Without pupil dilation.
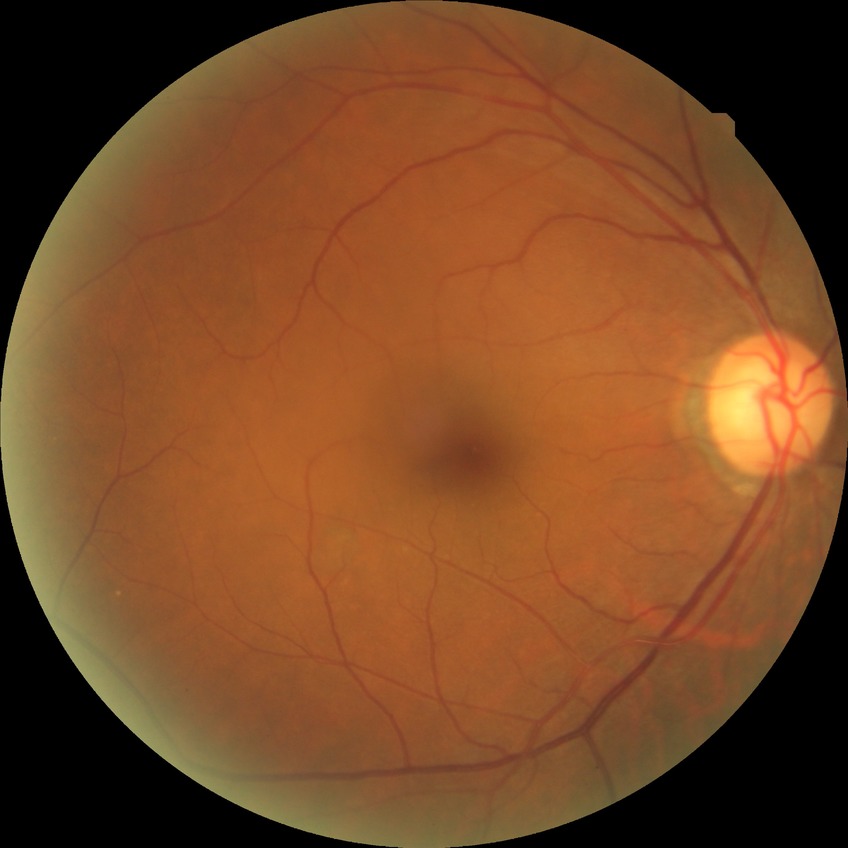
Diabetic retinopathy (DR): no diabetic retinopathy (NDR).